45° FOV. Davis DR grading — 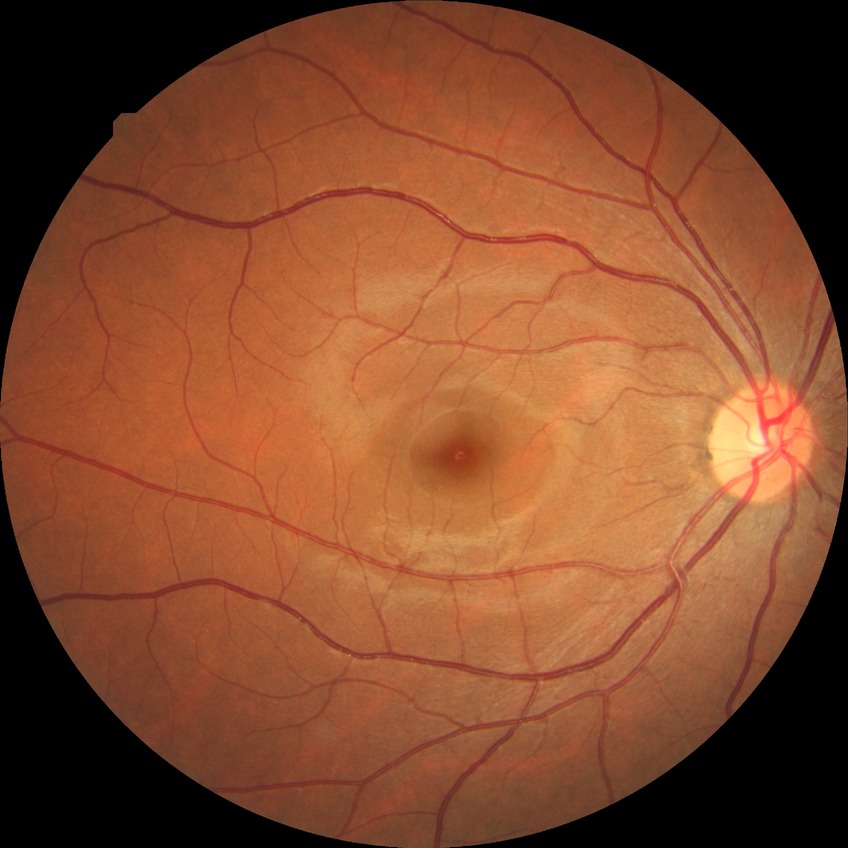 Diabetic retinopathy grade: no diabetic retinopathy.